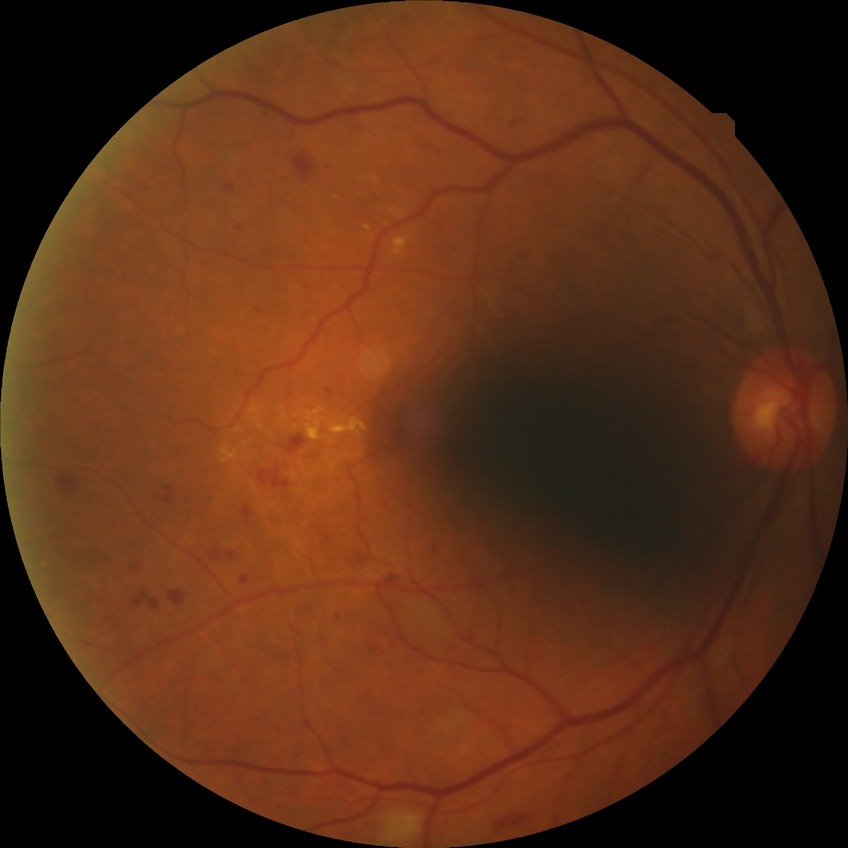 Modified Davis classification is pre-proliferative diabetic retinopathy.